640x480px; wide-field fundus image from infant ROP screening.
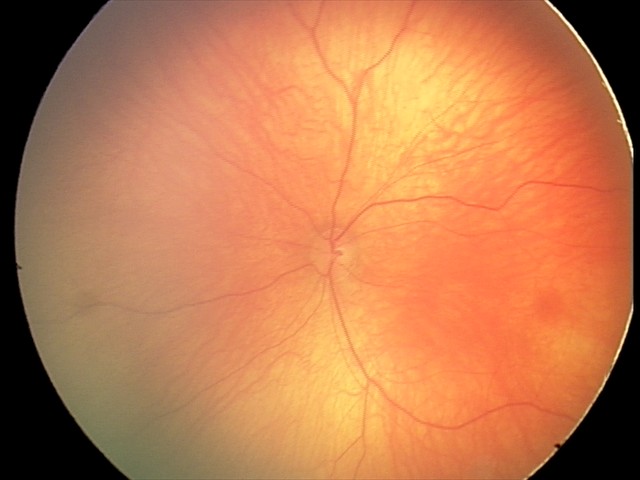 Screening diagnosis: physiological appearance with no retinal pathology.